Phoenix ICON wide-field infant fundus image · camera: Phoenix ICON (100° FOV) · 1240 by 1240 pixels: 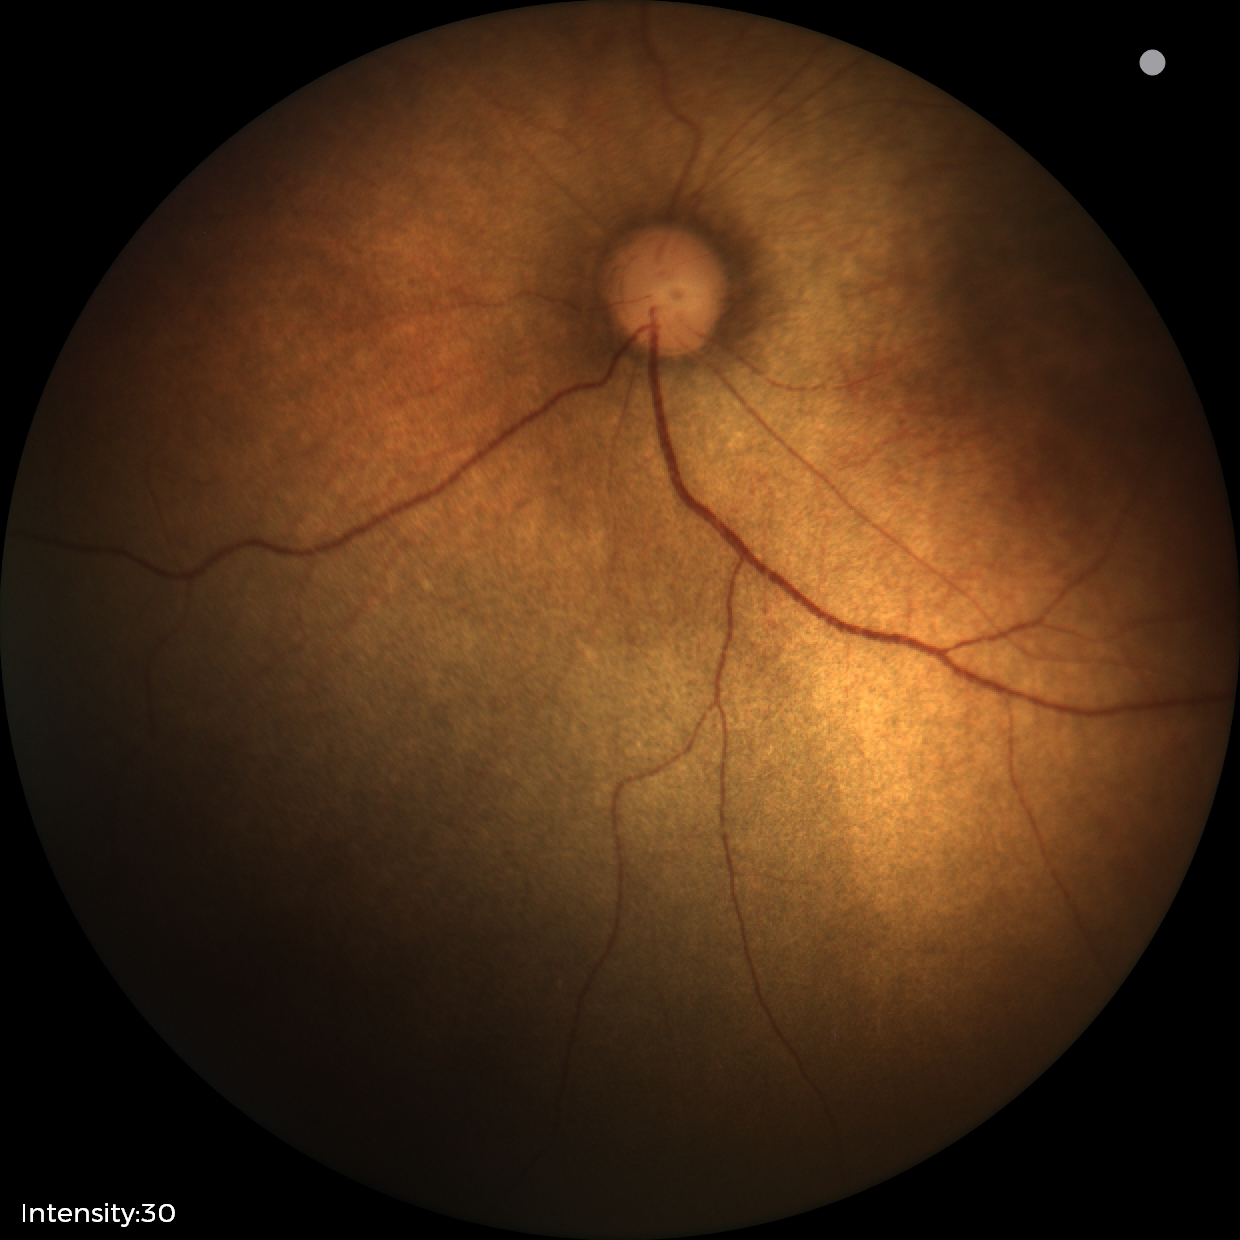

Normal screening examination.